Infant wide-field retinal image: 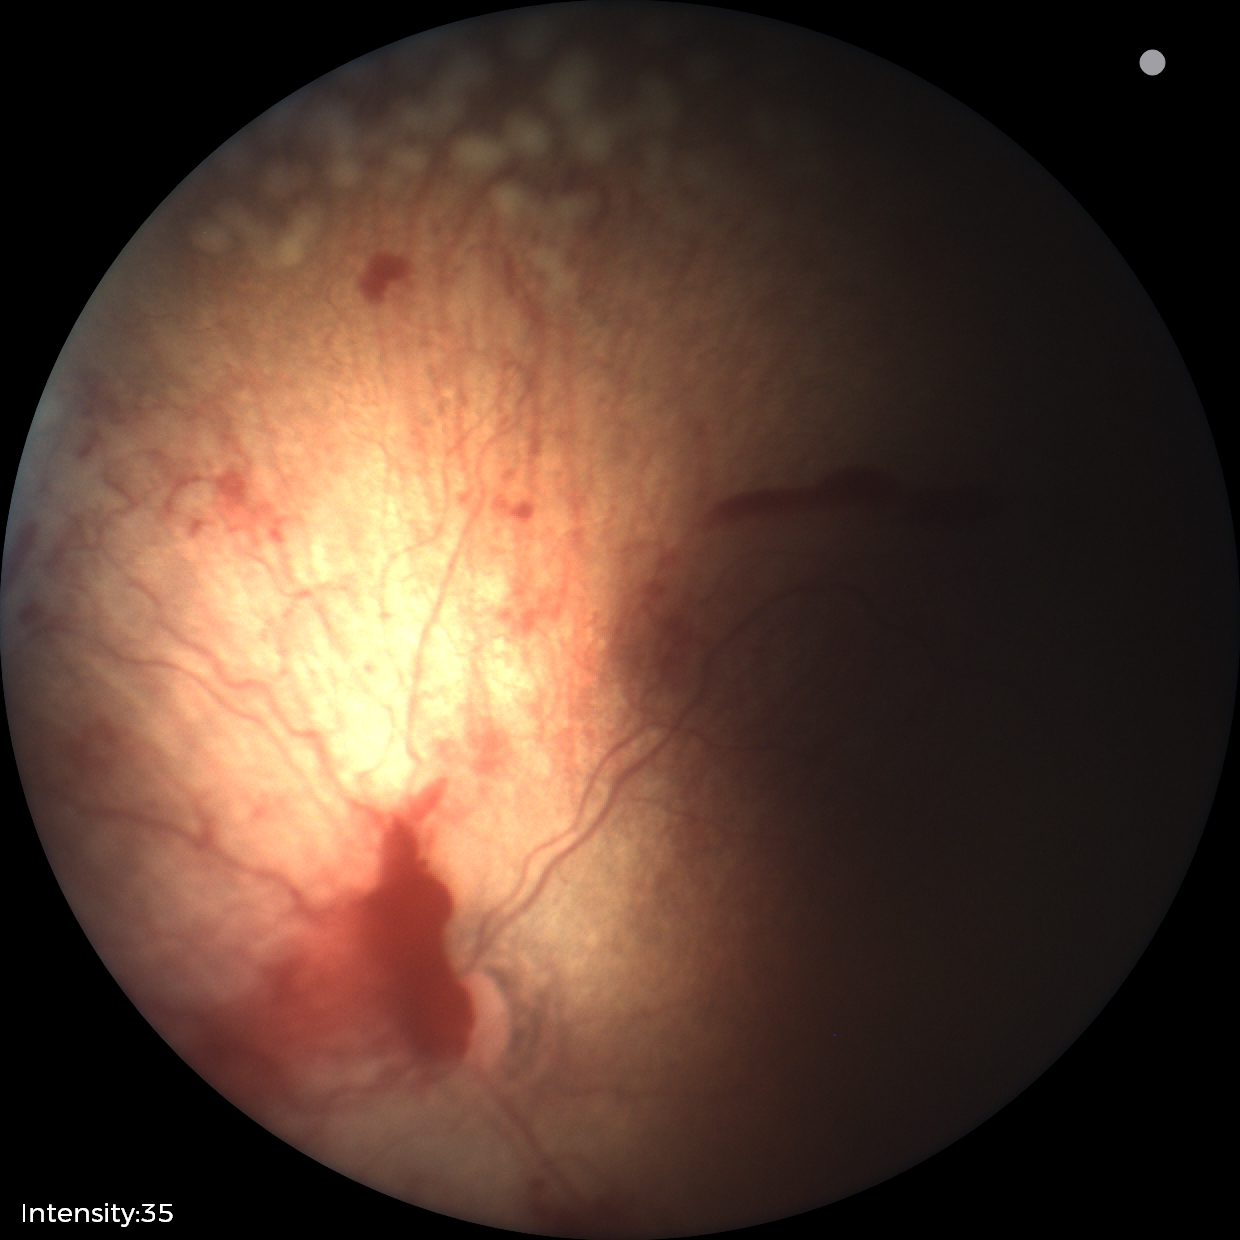

Series diagnosed as ROP stage 2.
Plus disease was diagnosed.